Retinal fundus photograph:
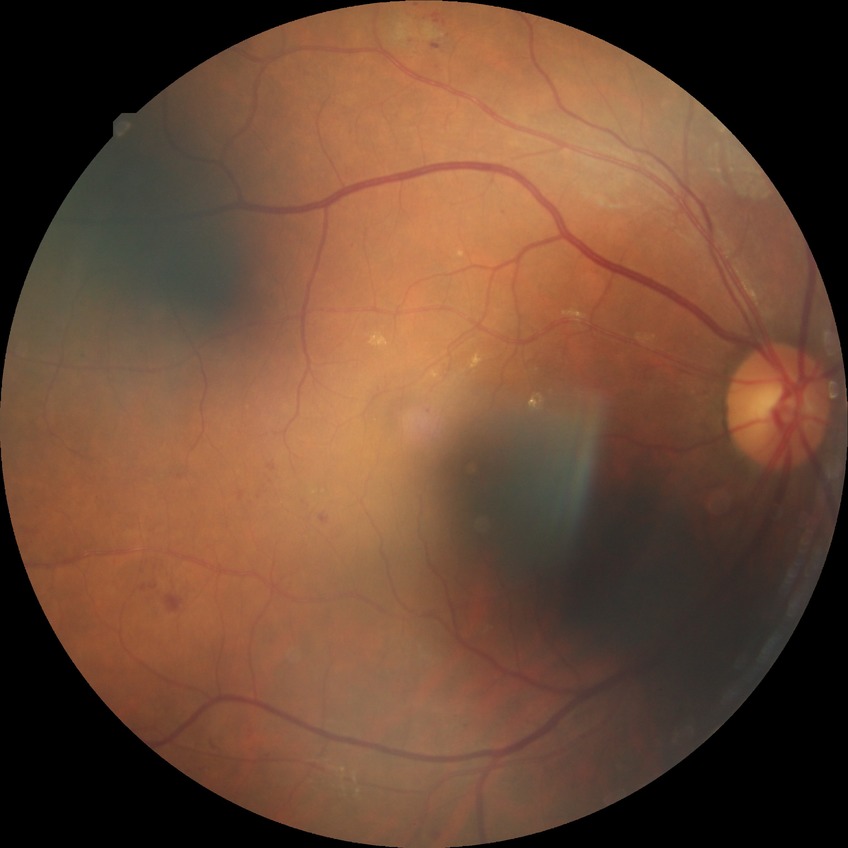

{
  "davis_grade": "SDR"
}